Wide-field contact fundus photograph of an infant · Clarity RetCam 3, 130° FOV · image size 640x480:
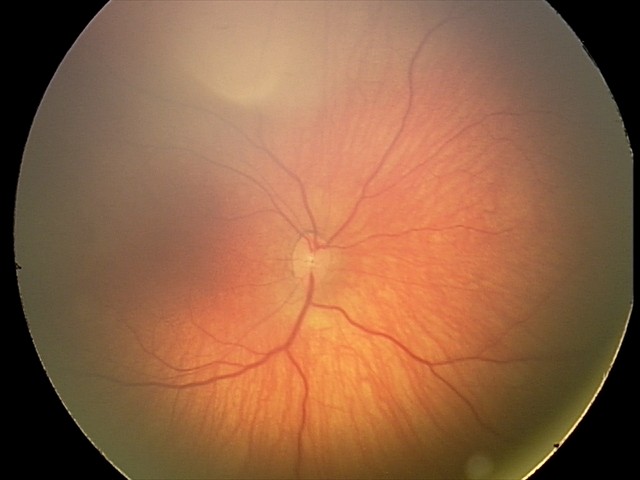
Assessment = retinal hemorrhages